50° FOV · 2361x1568px · tabletop color fundus camera image.
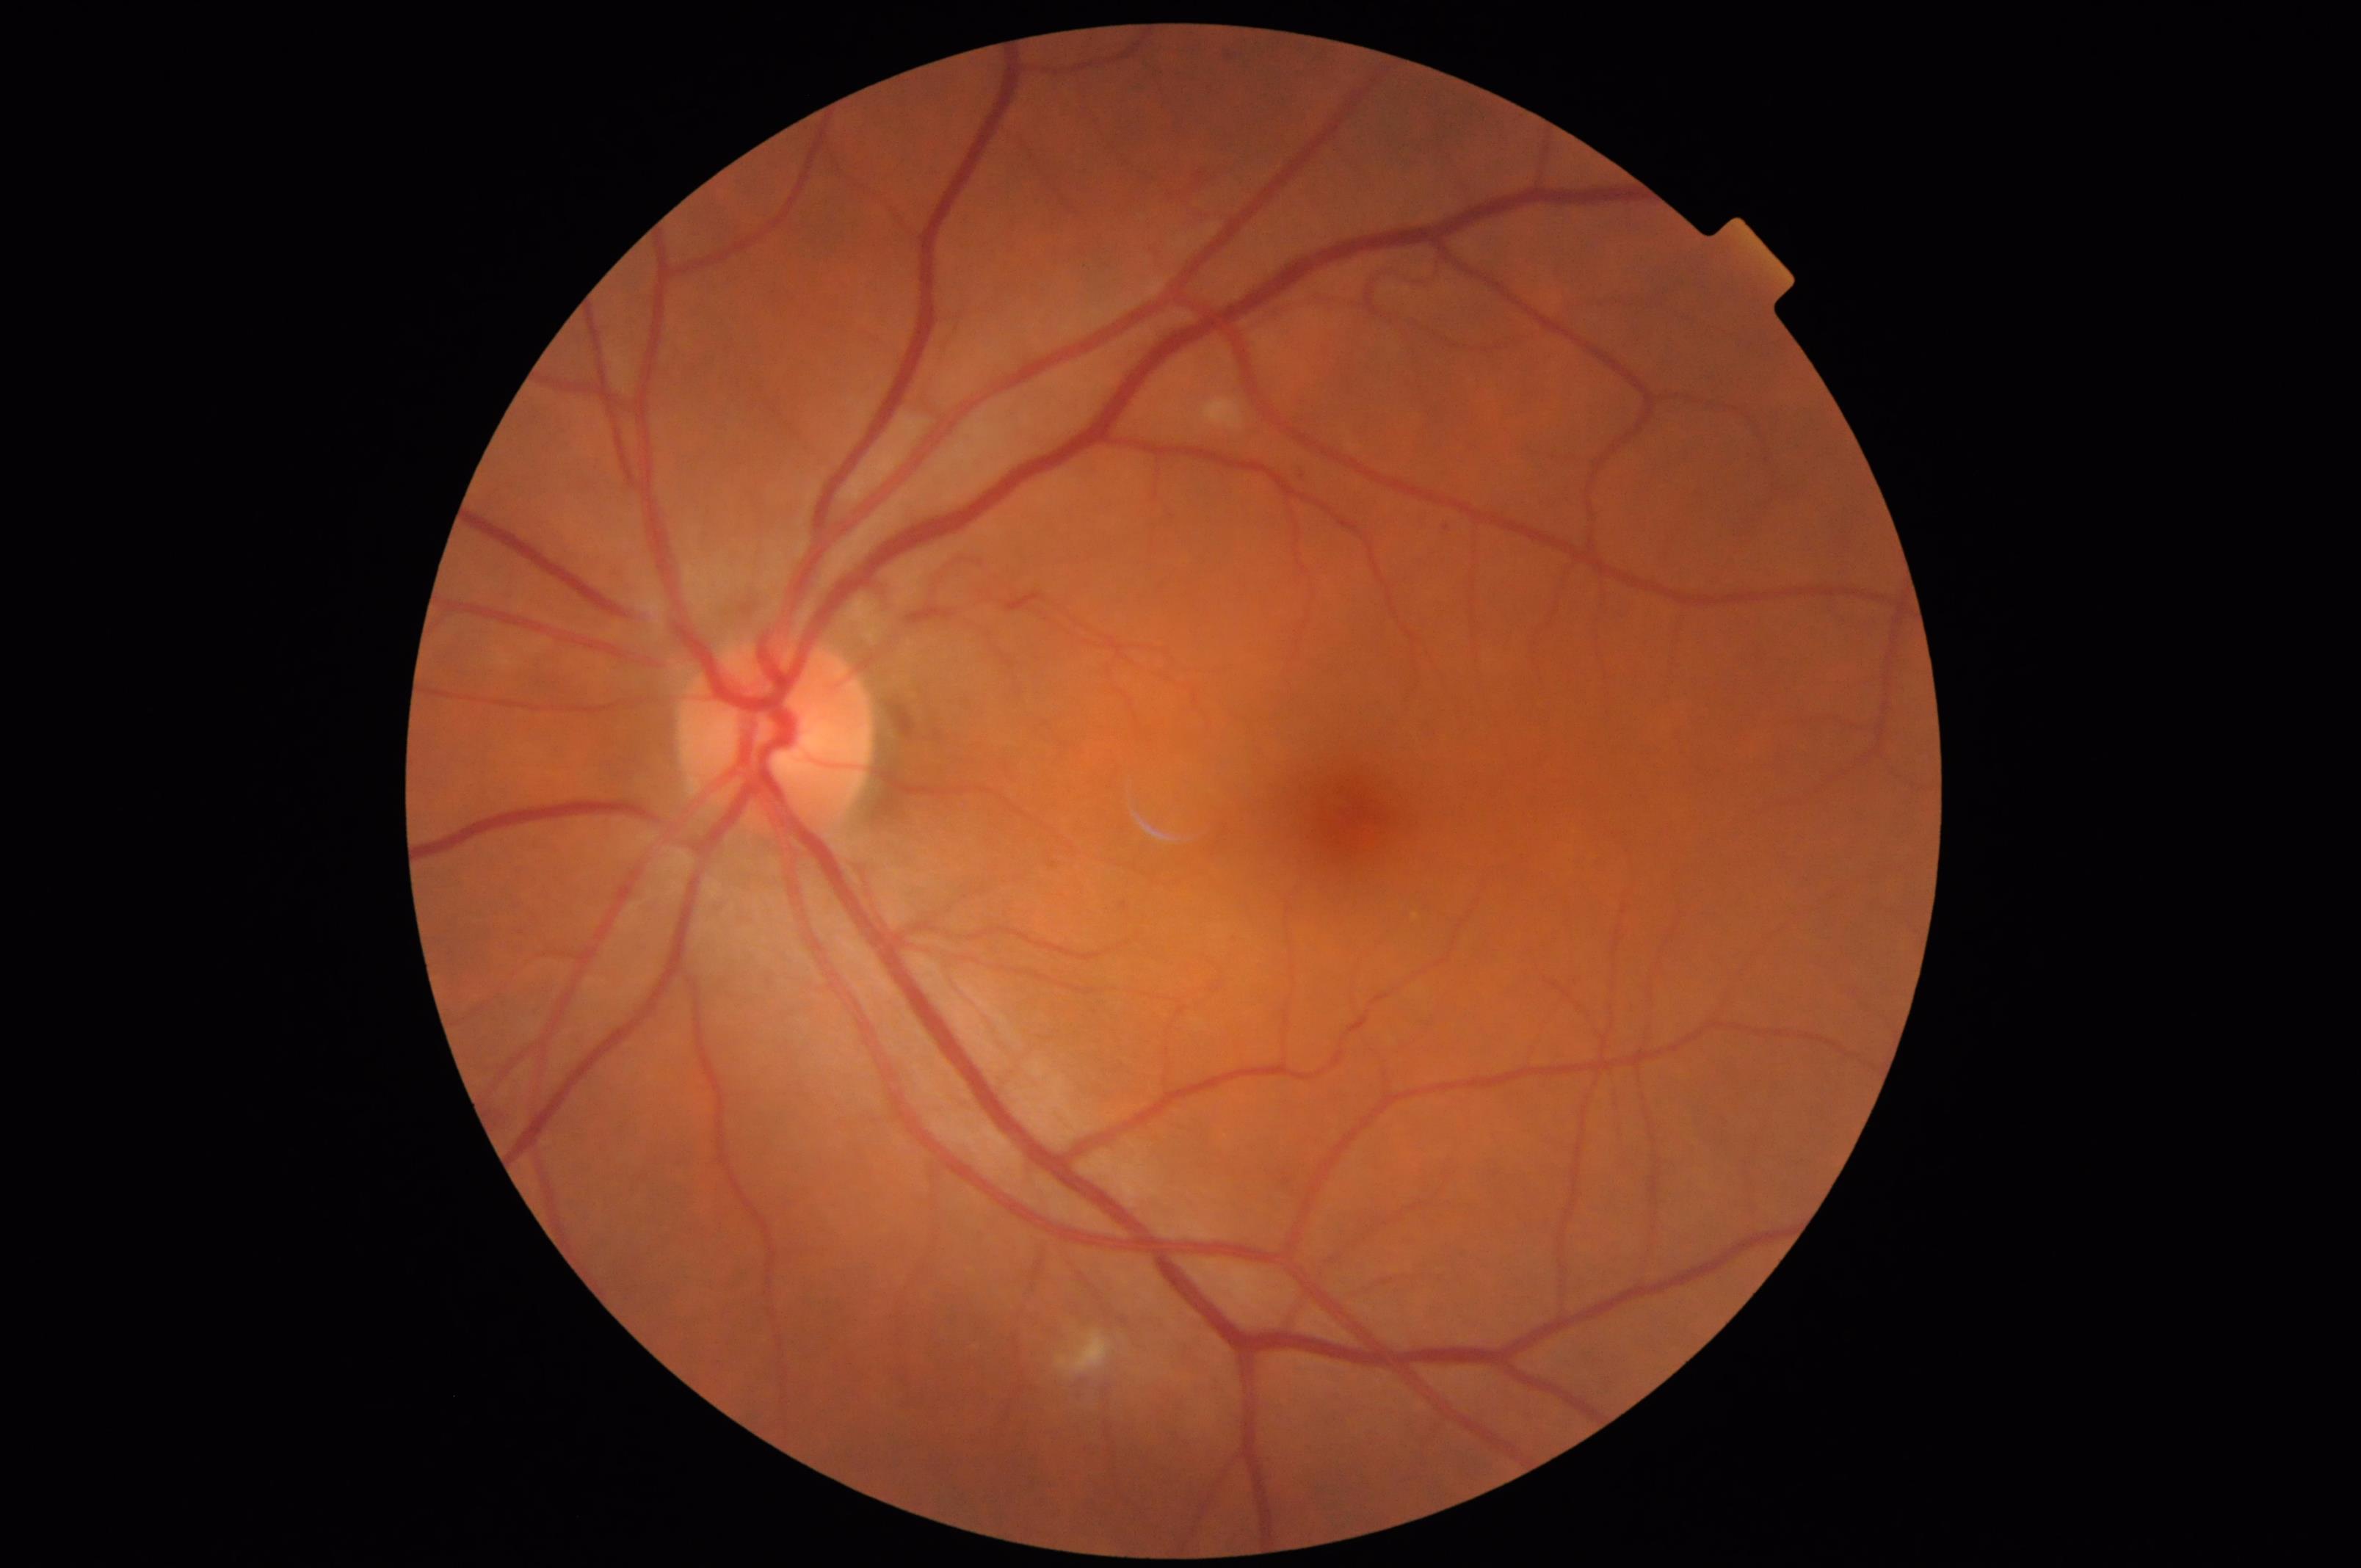 Clarity: optic disc, vessels, and background in focus; Overall: good and suitable for diagnostic use; Contrast: vessels and details readily distinguishable; Illumination: no over- or under-exposure.